45° FOV; image size 2352x1568:
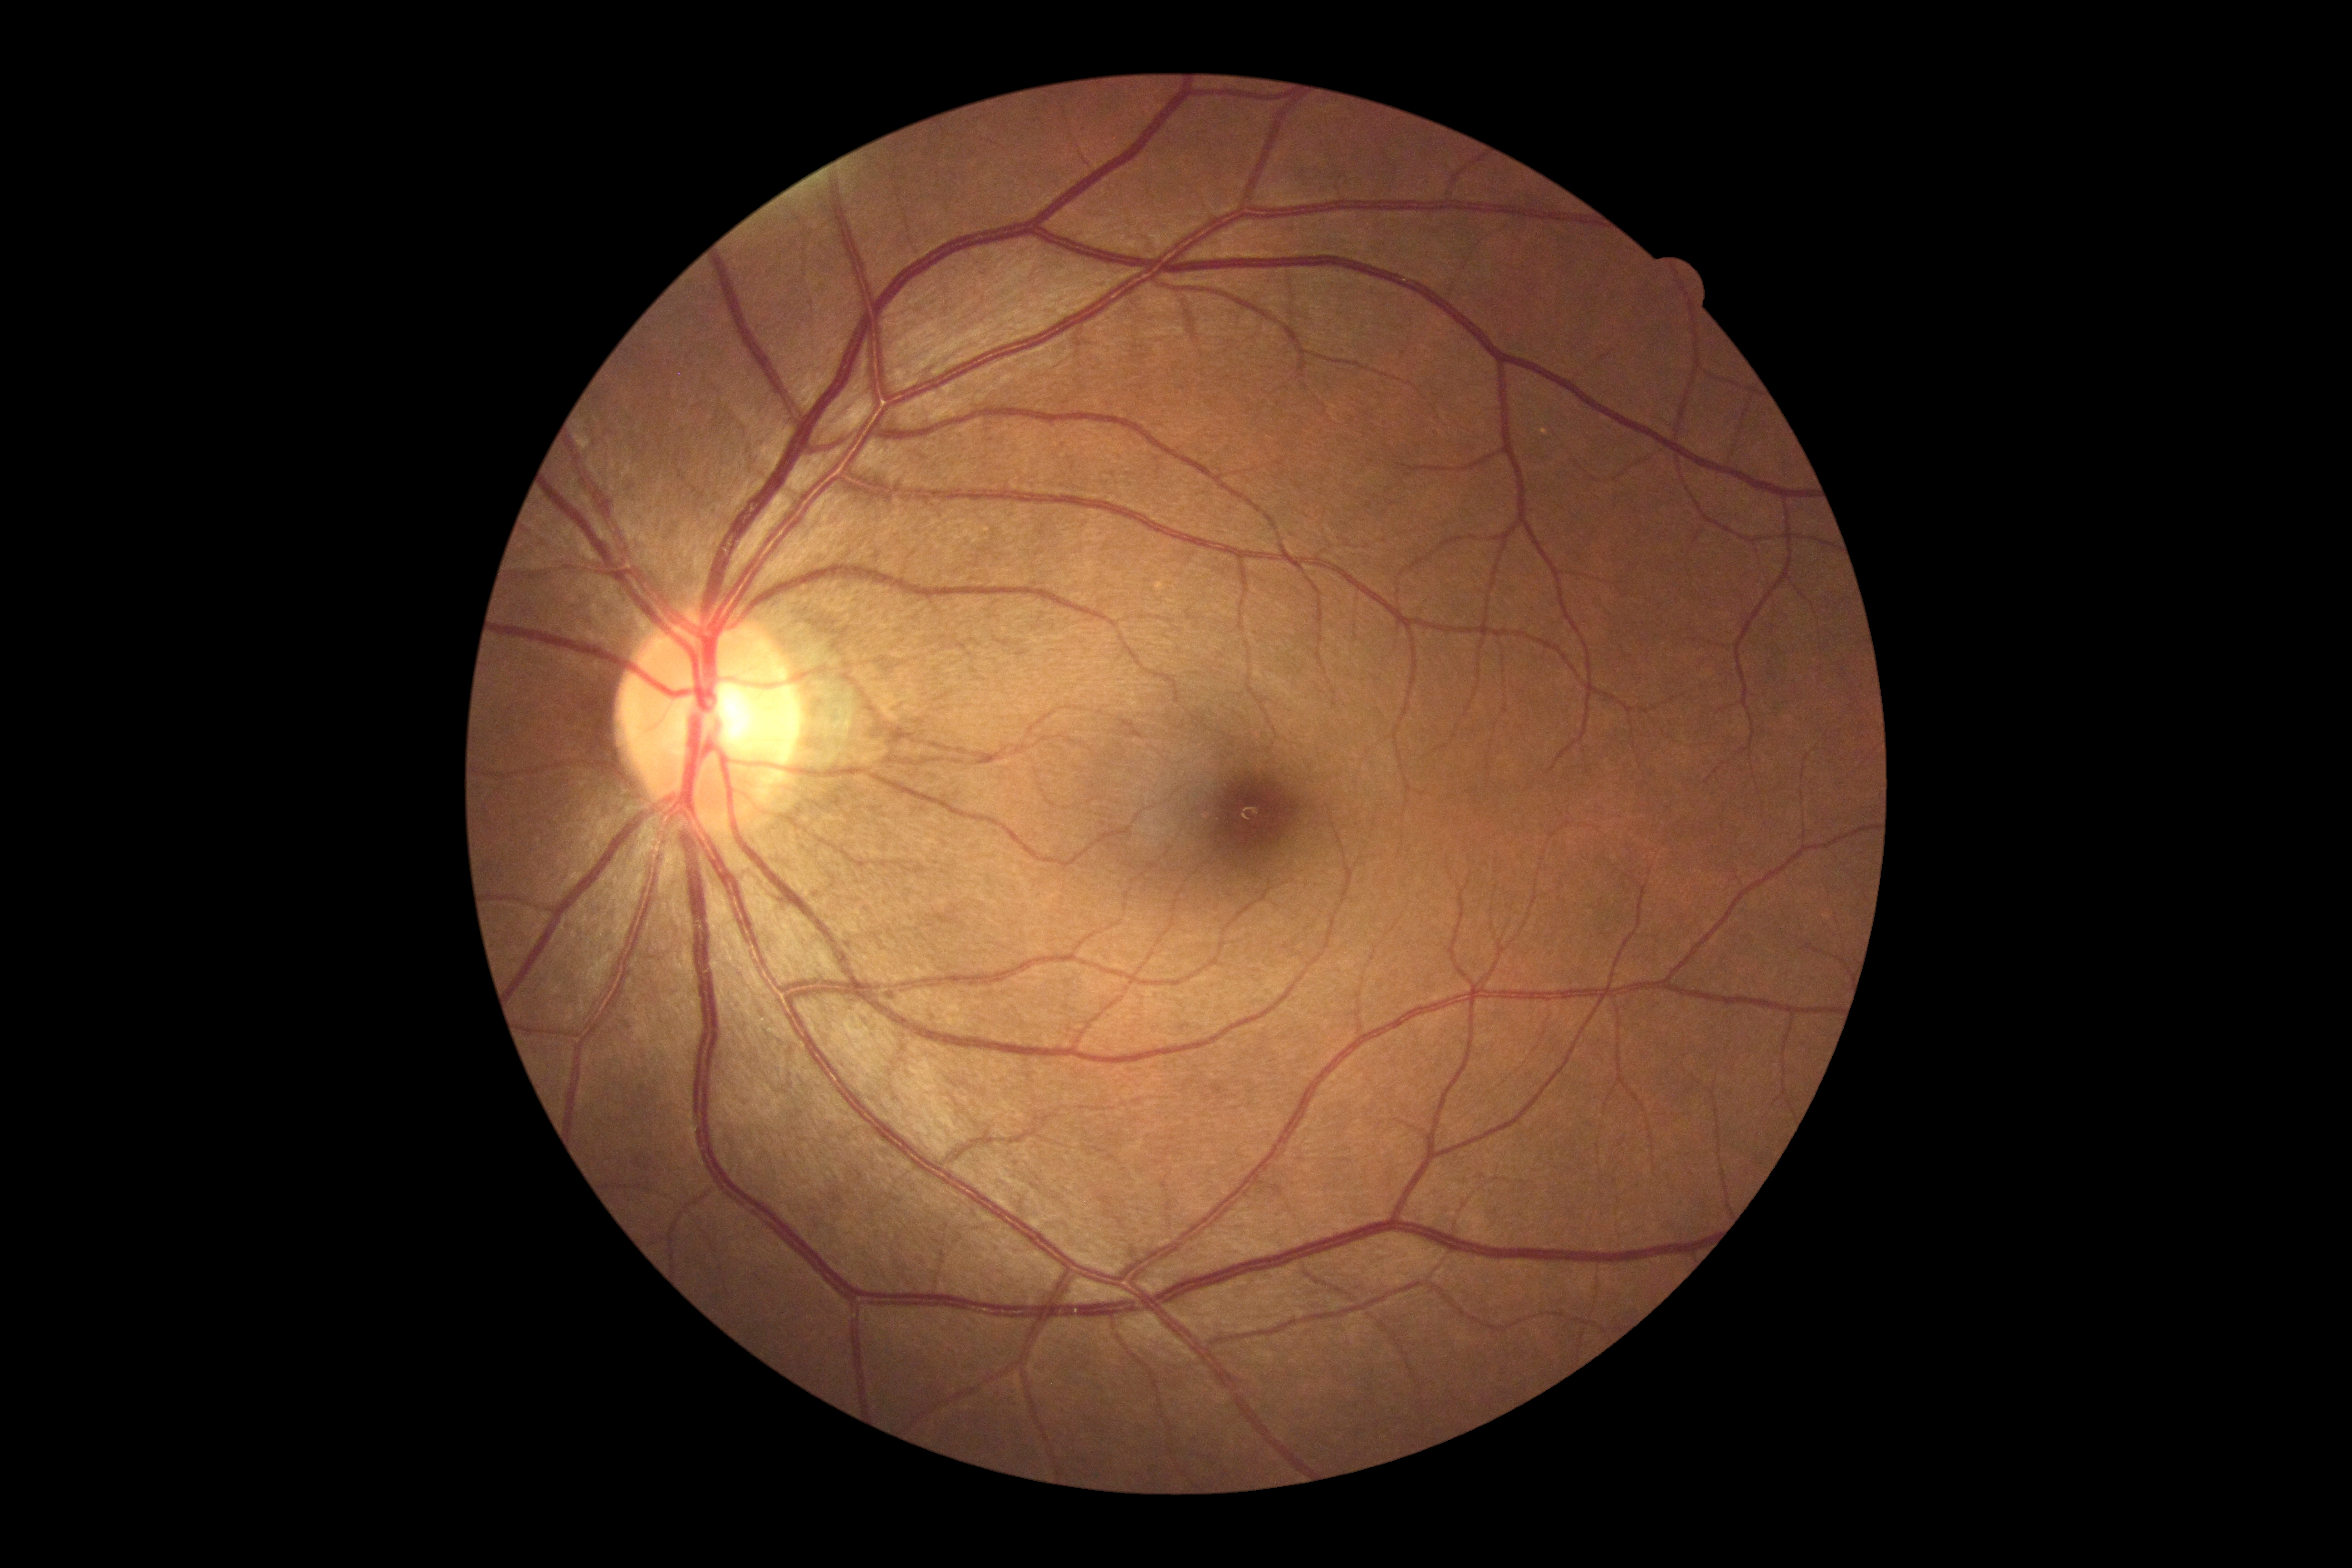
diabetic retinopathy severity: grade 0 (no apparent retinopathy).